Image size 2212x1659.
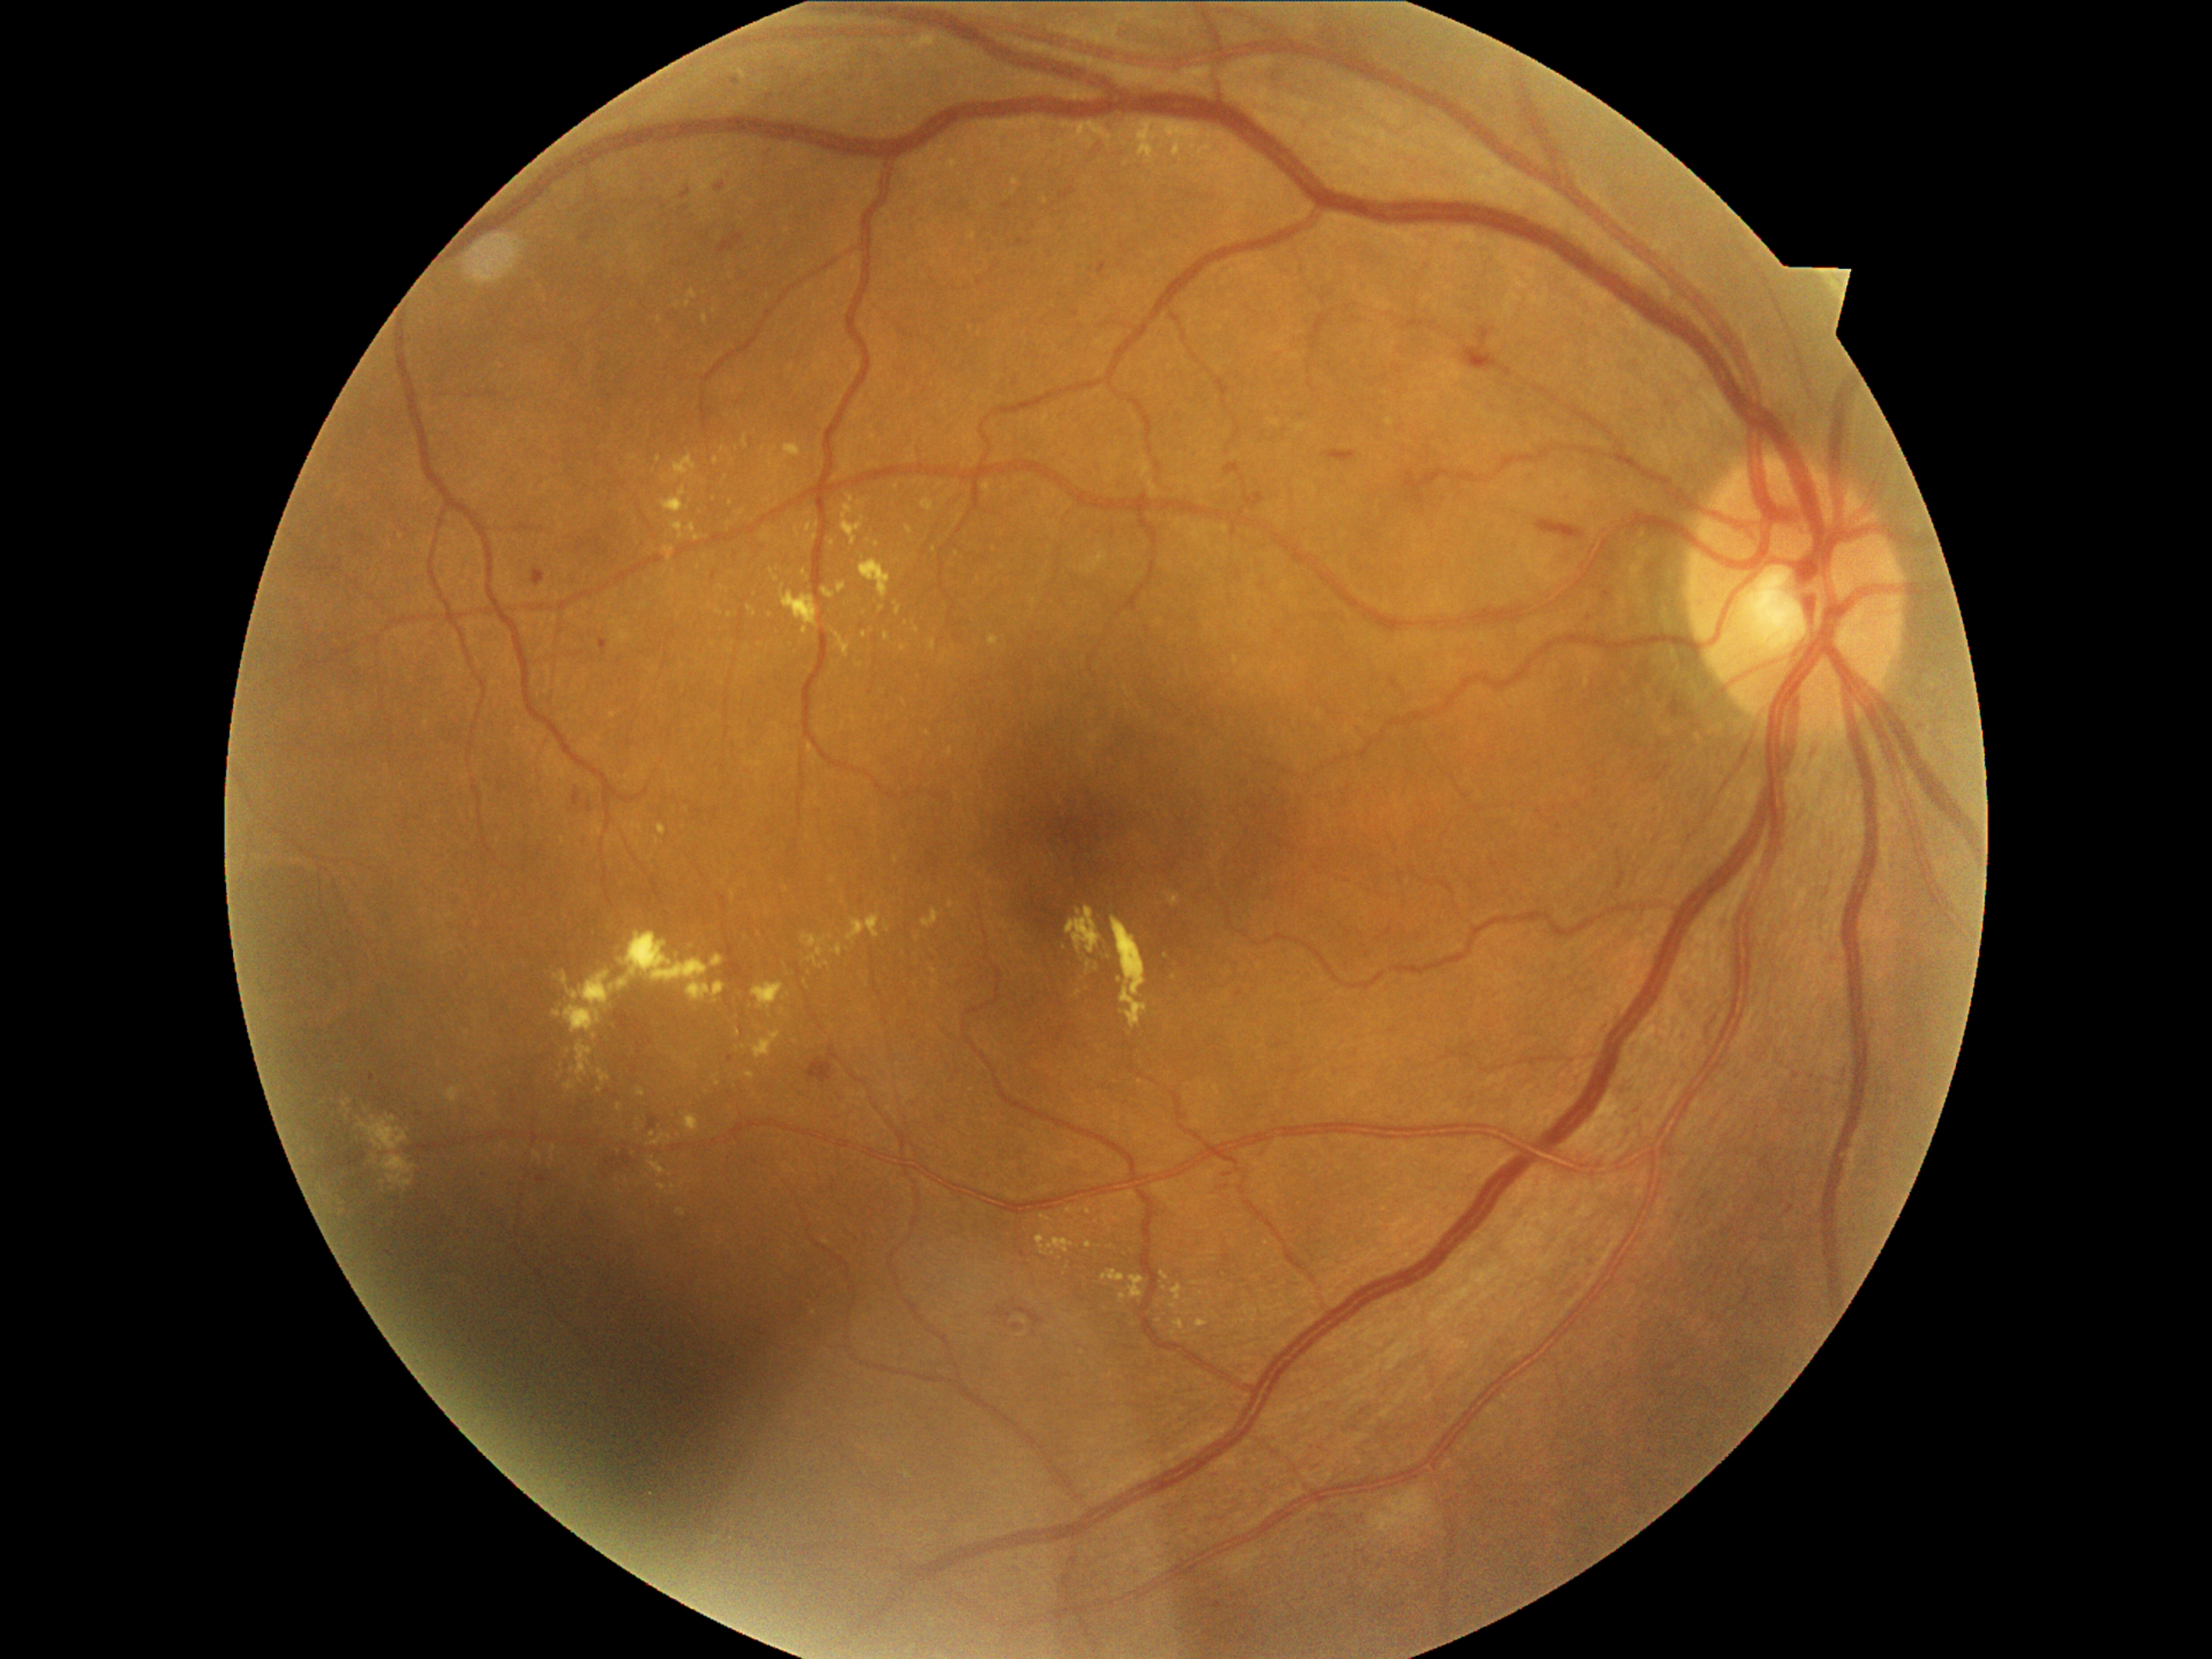

Diabetic retinopathy (DR) is moderate non-proliferative diabetic retinopathy (grade 2) — more than just microaneurysms but less than severe NPDR
Representative lesions:
hard exudates (EXs) (continued): <bbox>672, 521, 685, 540</bbox>; <bbox>1086, 962, 1091, 974</bbox>; <bbox>1143, 141, 1151, 154</bbox>; <bbox>665, 547, 675, 561</bbox>; <bbox>689, 291, 697, 300</bbox>; <bbox>1129, 1276, 1146, 1300</bbox>; <bbox>1139, 124, 1148, 136</bbox>; <bbox>1085, 1242, 1091, 1250</bbox>; <bbox>359, 1117, 409, 1151</bbox>; <bbox>752, 982, 784, 1010</bbox>
Small EXs near [619,1108]; [832,938]; [660,320]; [916,630]; [1077,994]; [788,543]; [671,1175]; [1088,1211]